RetCam wide-field infant fundus image. Clarity RetCam 3, 130° FOV — 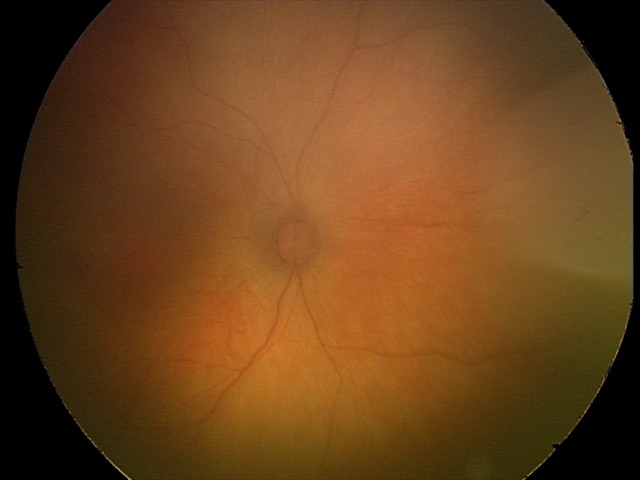 No retinal pathology identified on screening.